2102x1736, fundus photo.
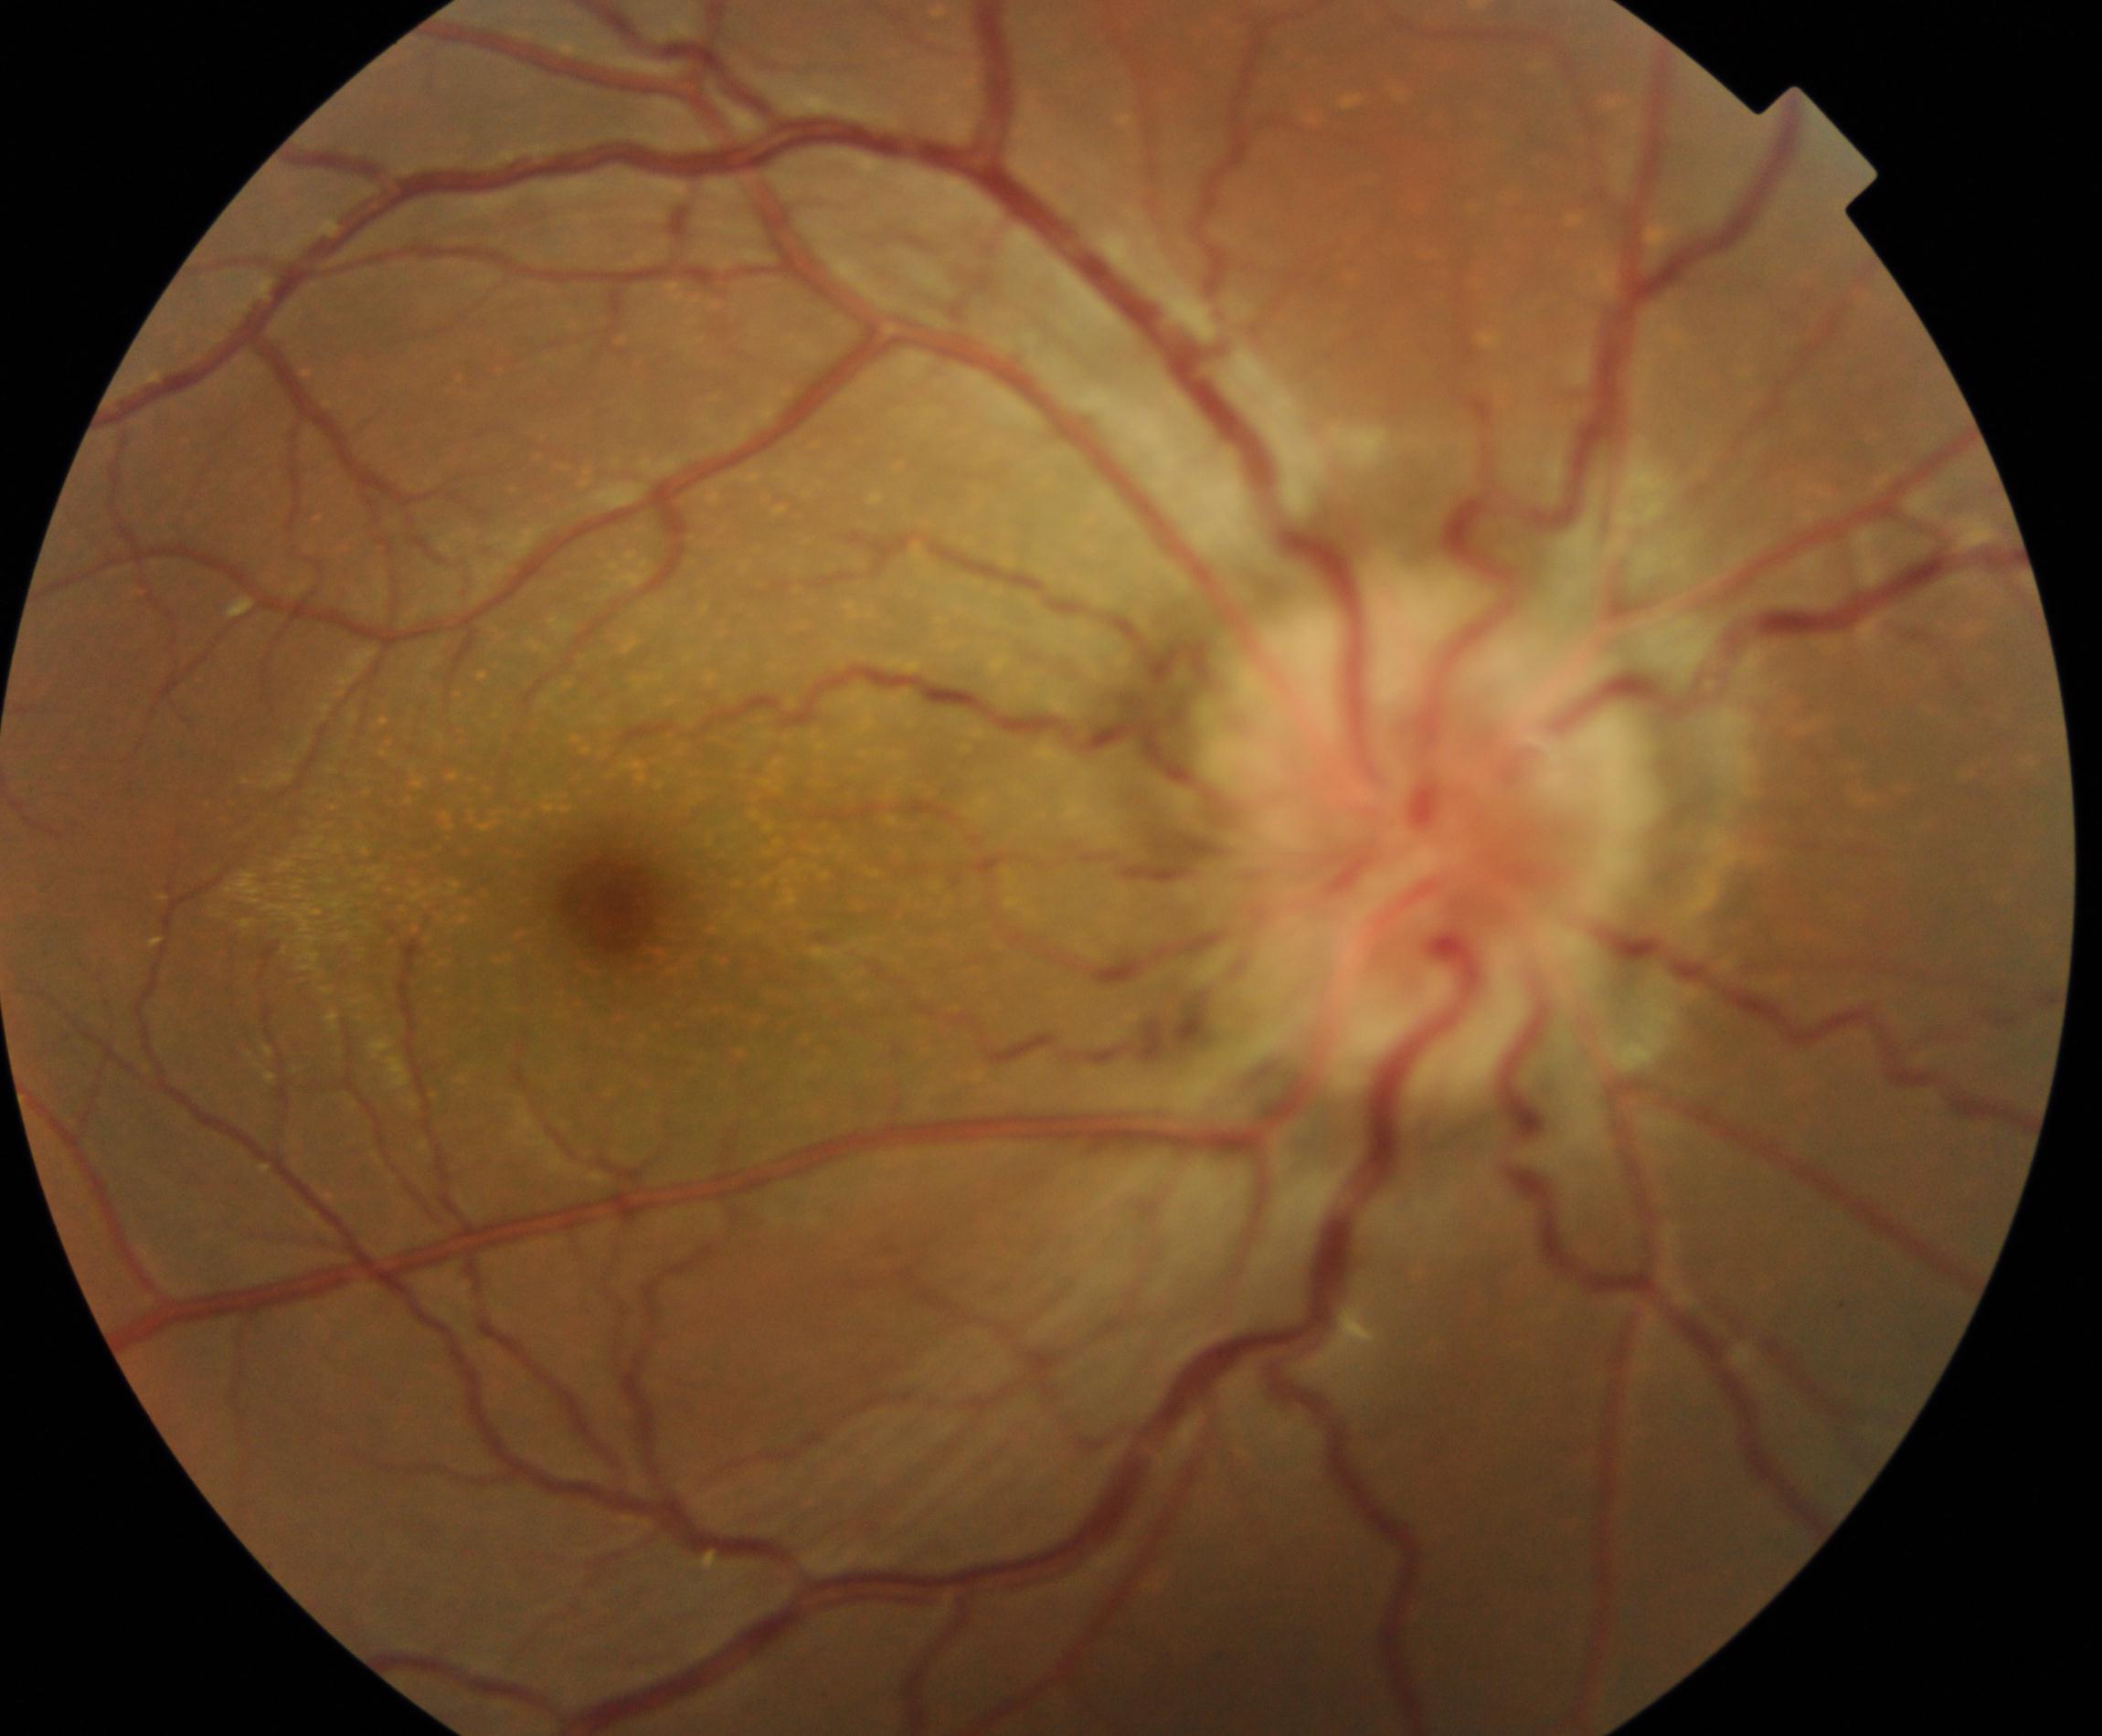
There is evidence of disc swelling and elevation.